Fundus photo: 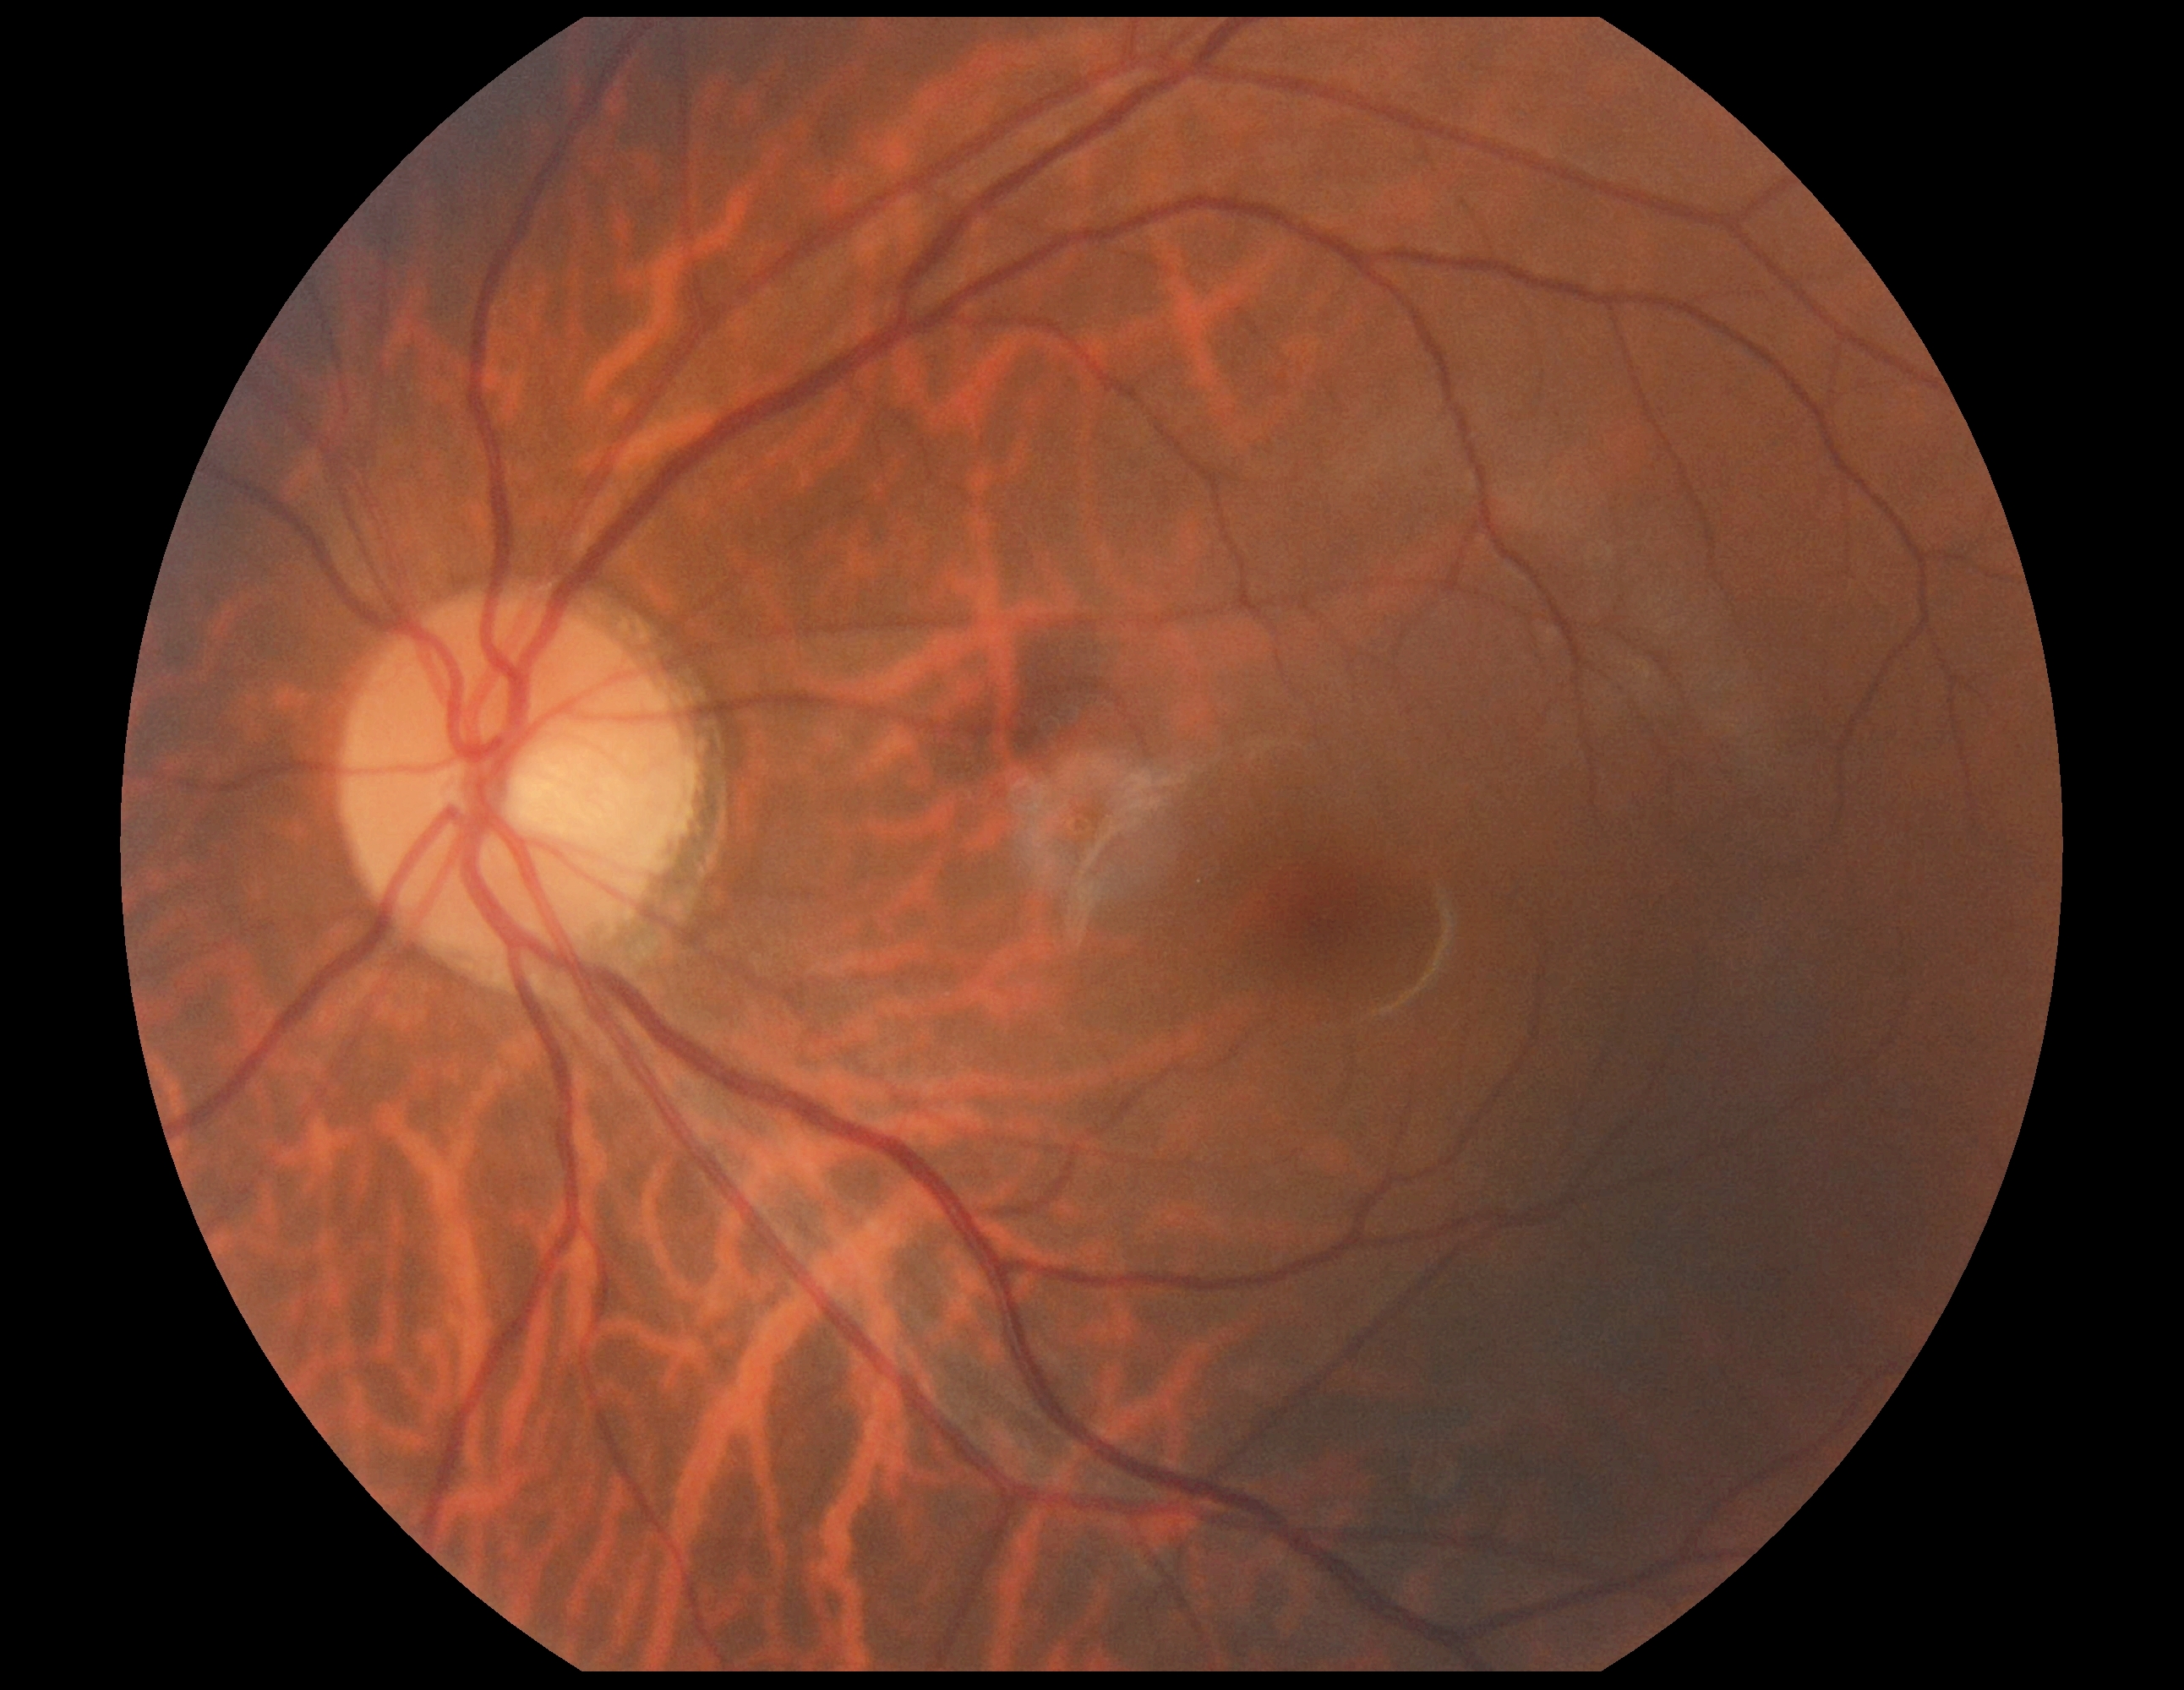 retinopathy: grade 0 (no apparent retinopathy).